CFP:
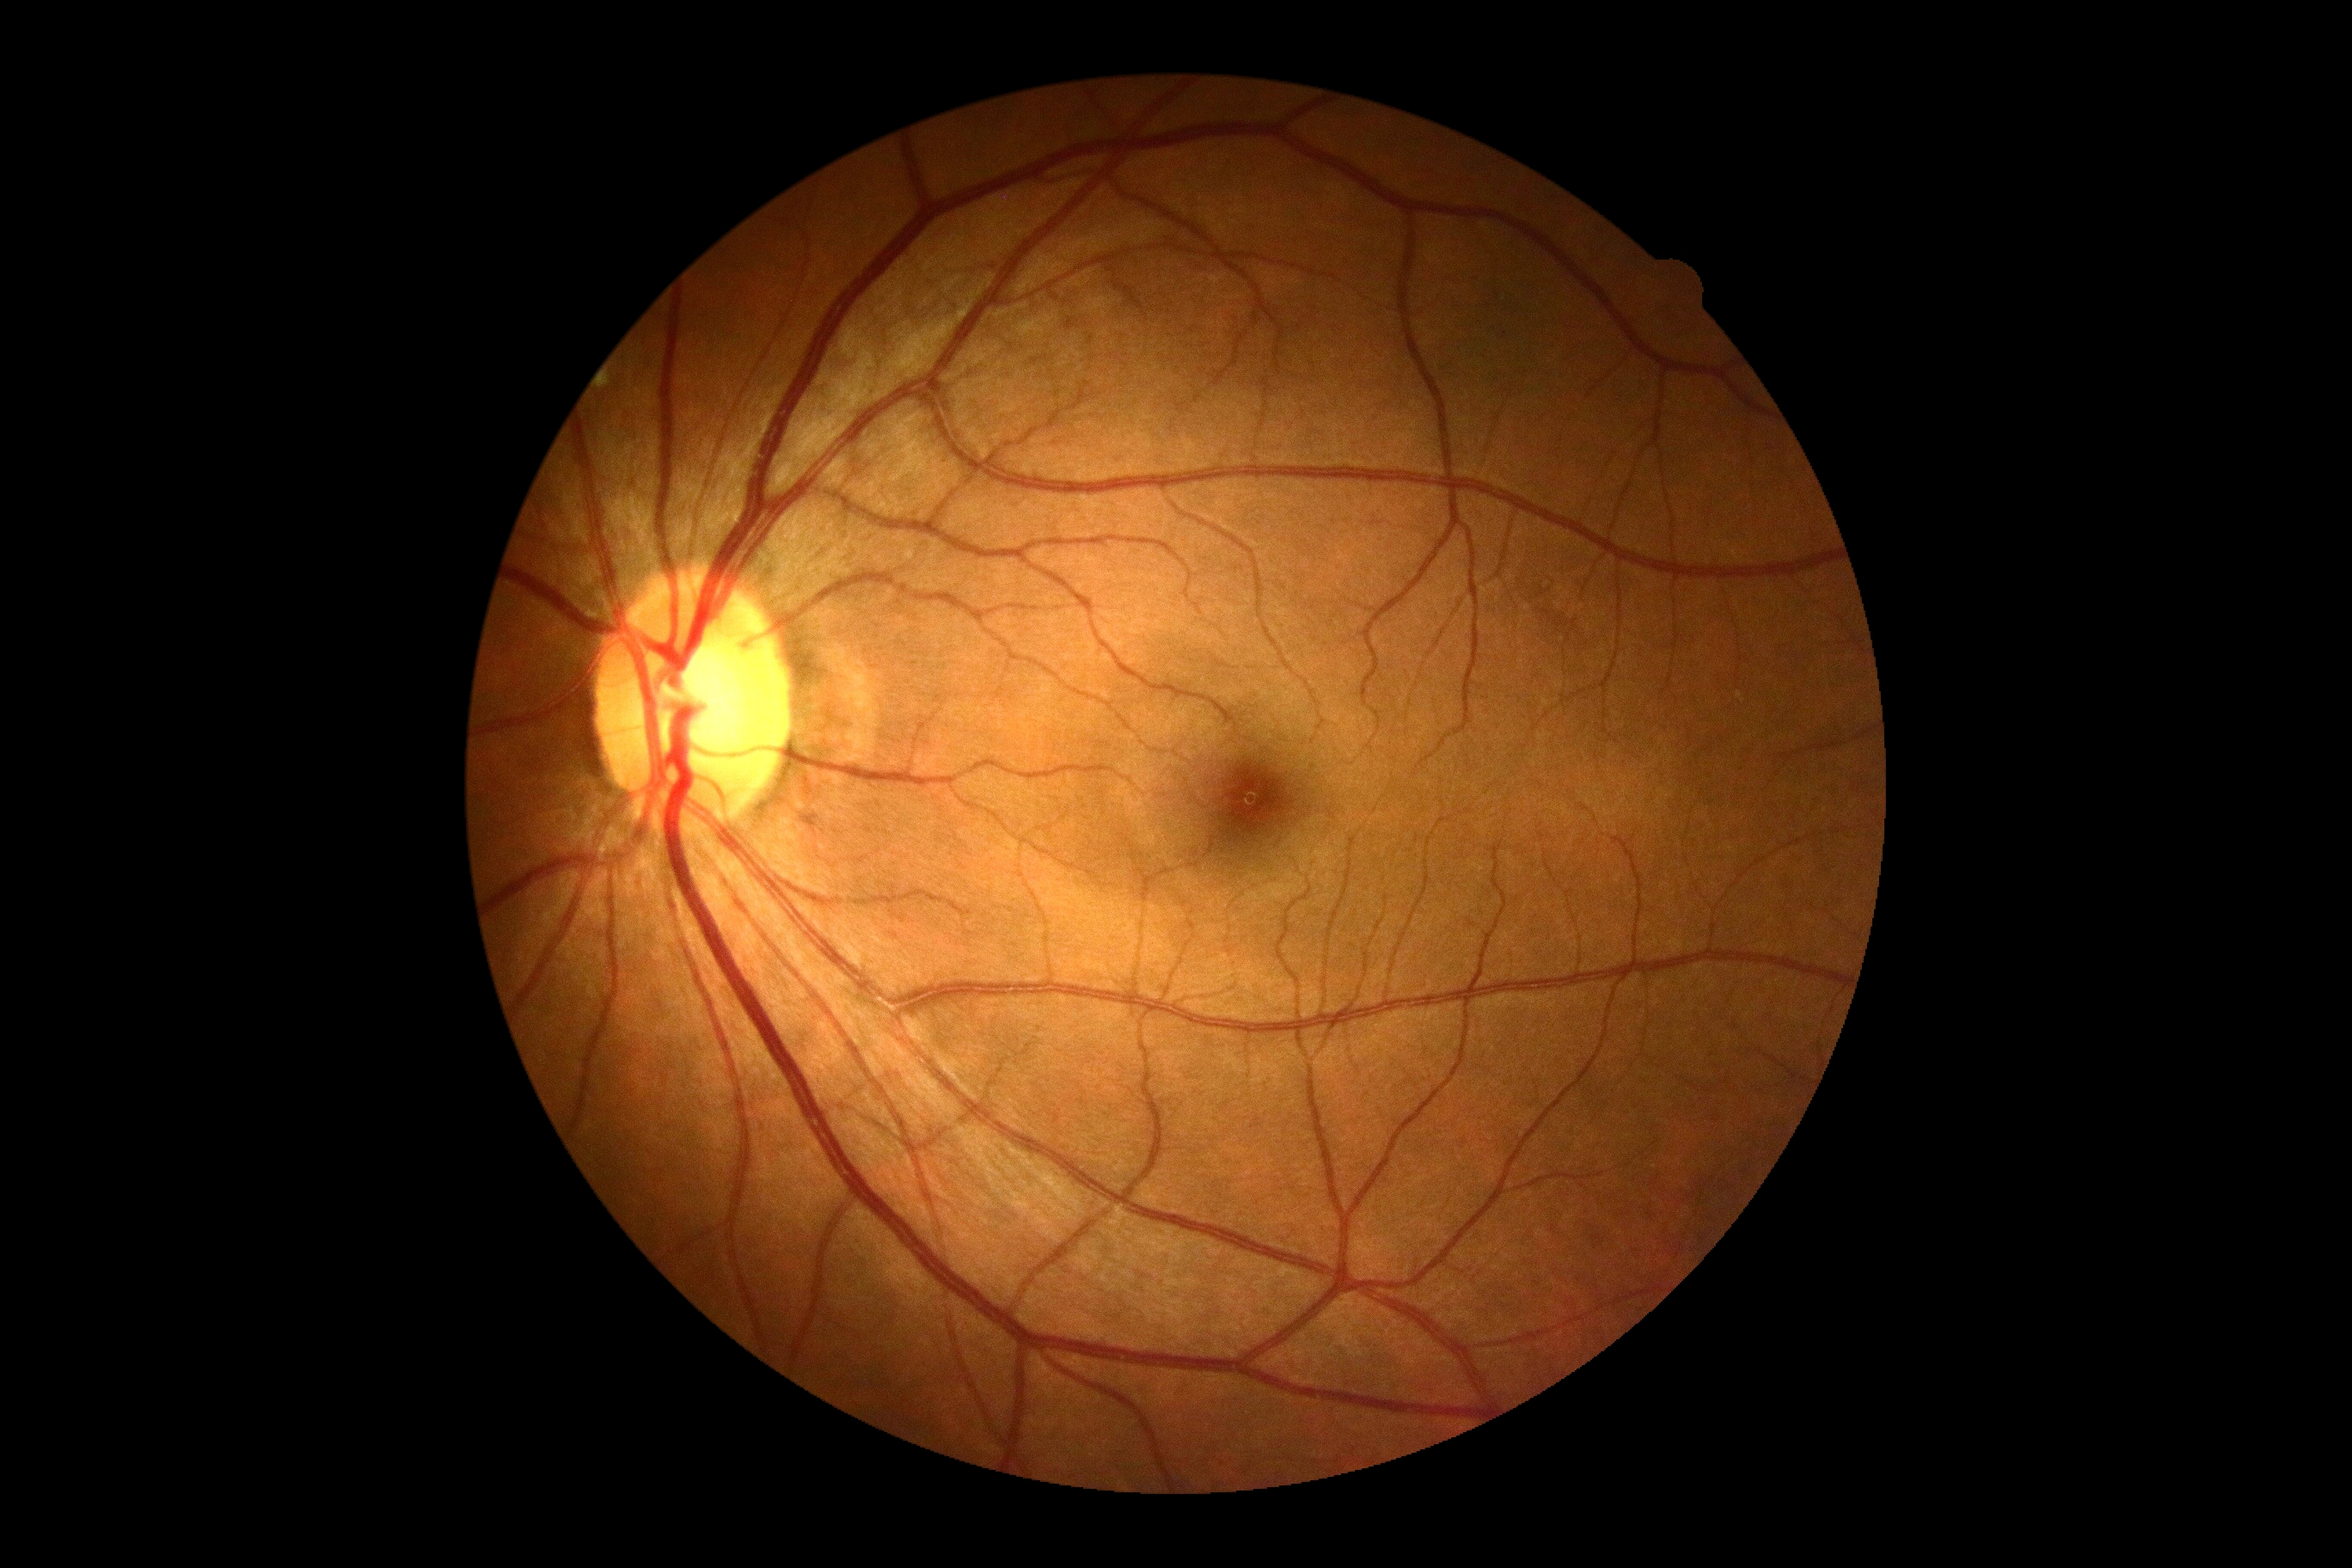
DR grade is 0/4. No signs of diabetic retinopathy.